1240x1240. Pediatric retinal photograph (wide-field):
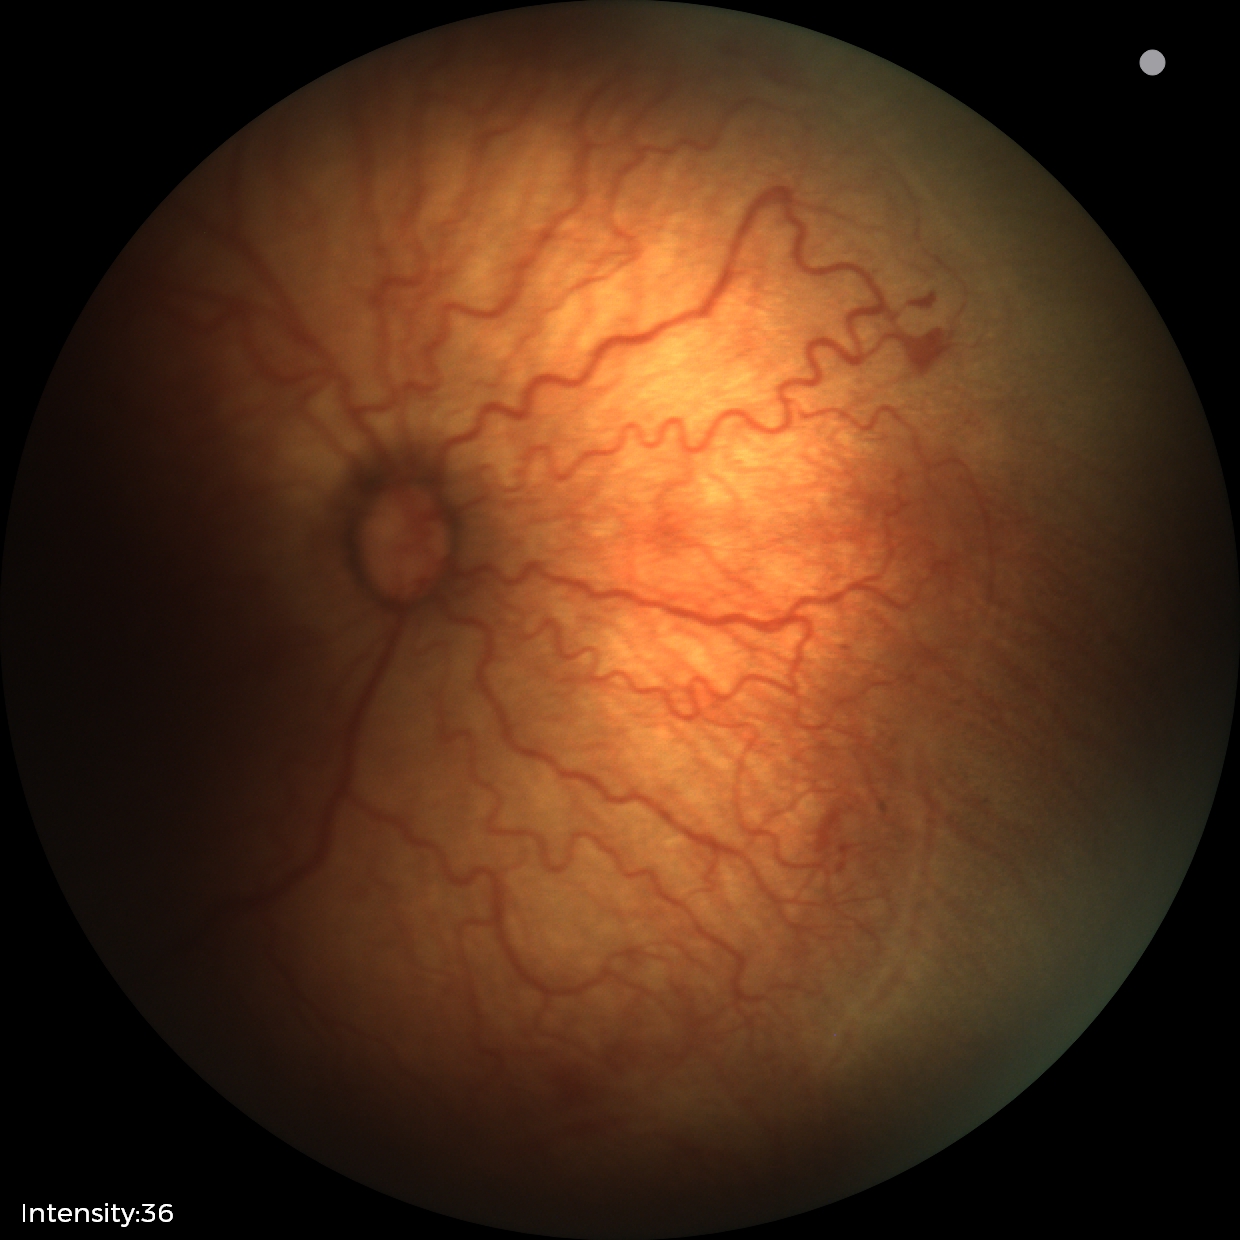
Examination diagnosed as retinopathy of prematurity stage 2.